Posterior pole photograph — 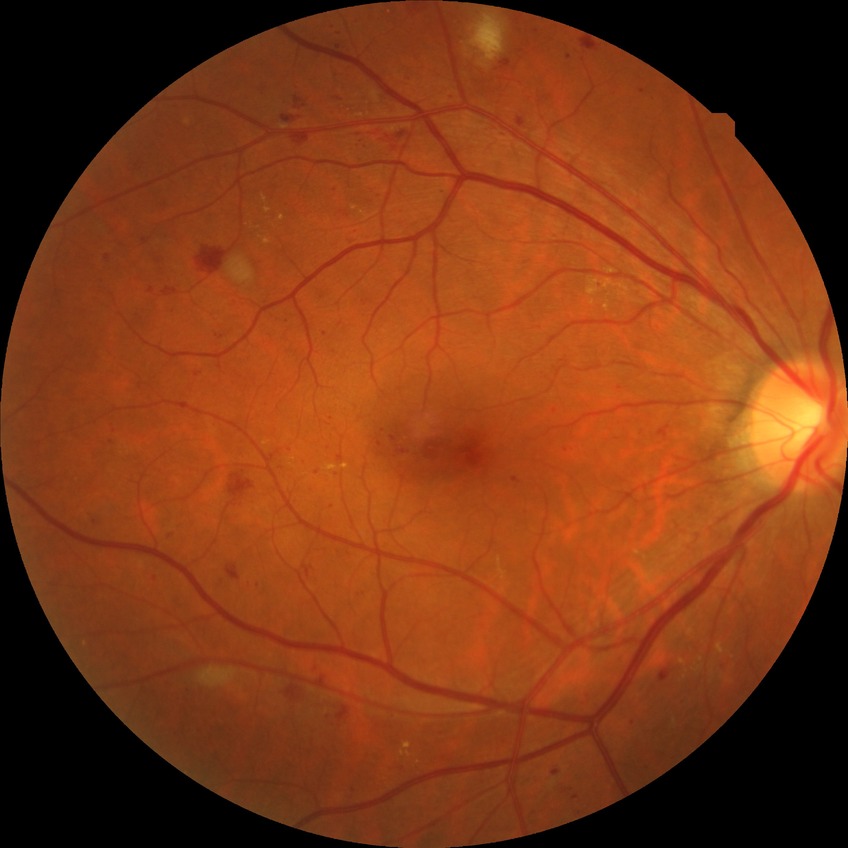
Davis grading is proliferative diabetic retinopathy.